NIDEK AFC-230 — 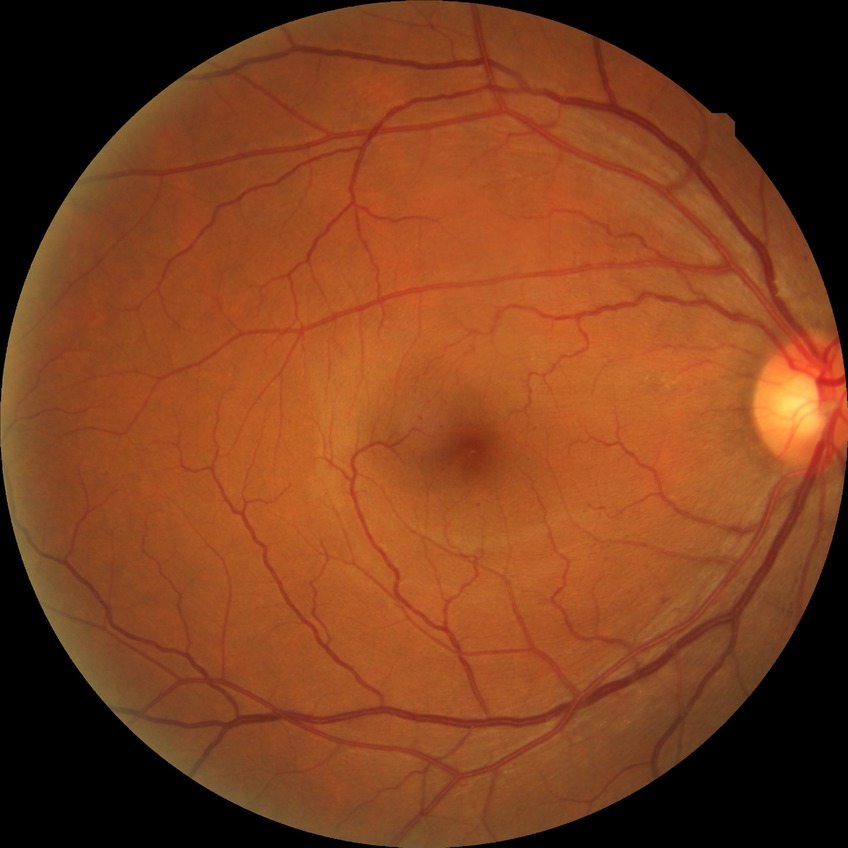

Diabetic retinopathy (DR): SDR (simple diabetic retinopathy).